Cropped from a 35-degree field of view. Optic nerve head photograph
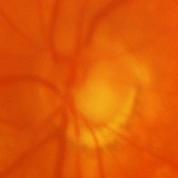 Optic disc appearance consistent with evidence of glaucoma.